Image size 1659x2212:
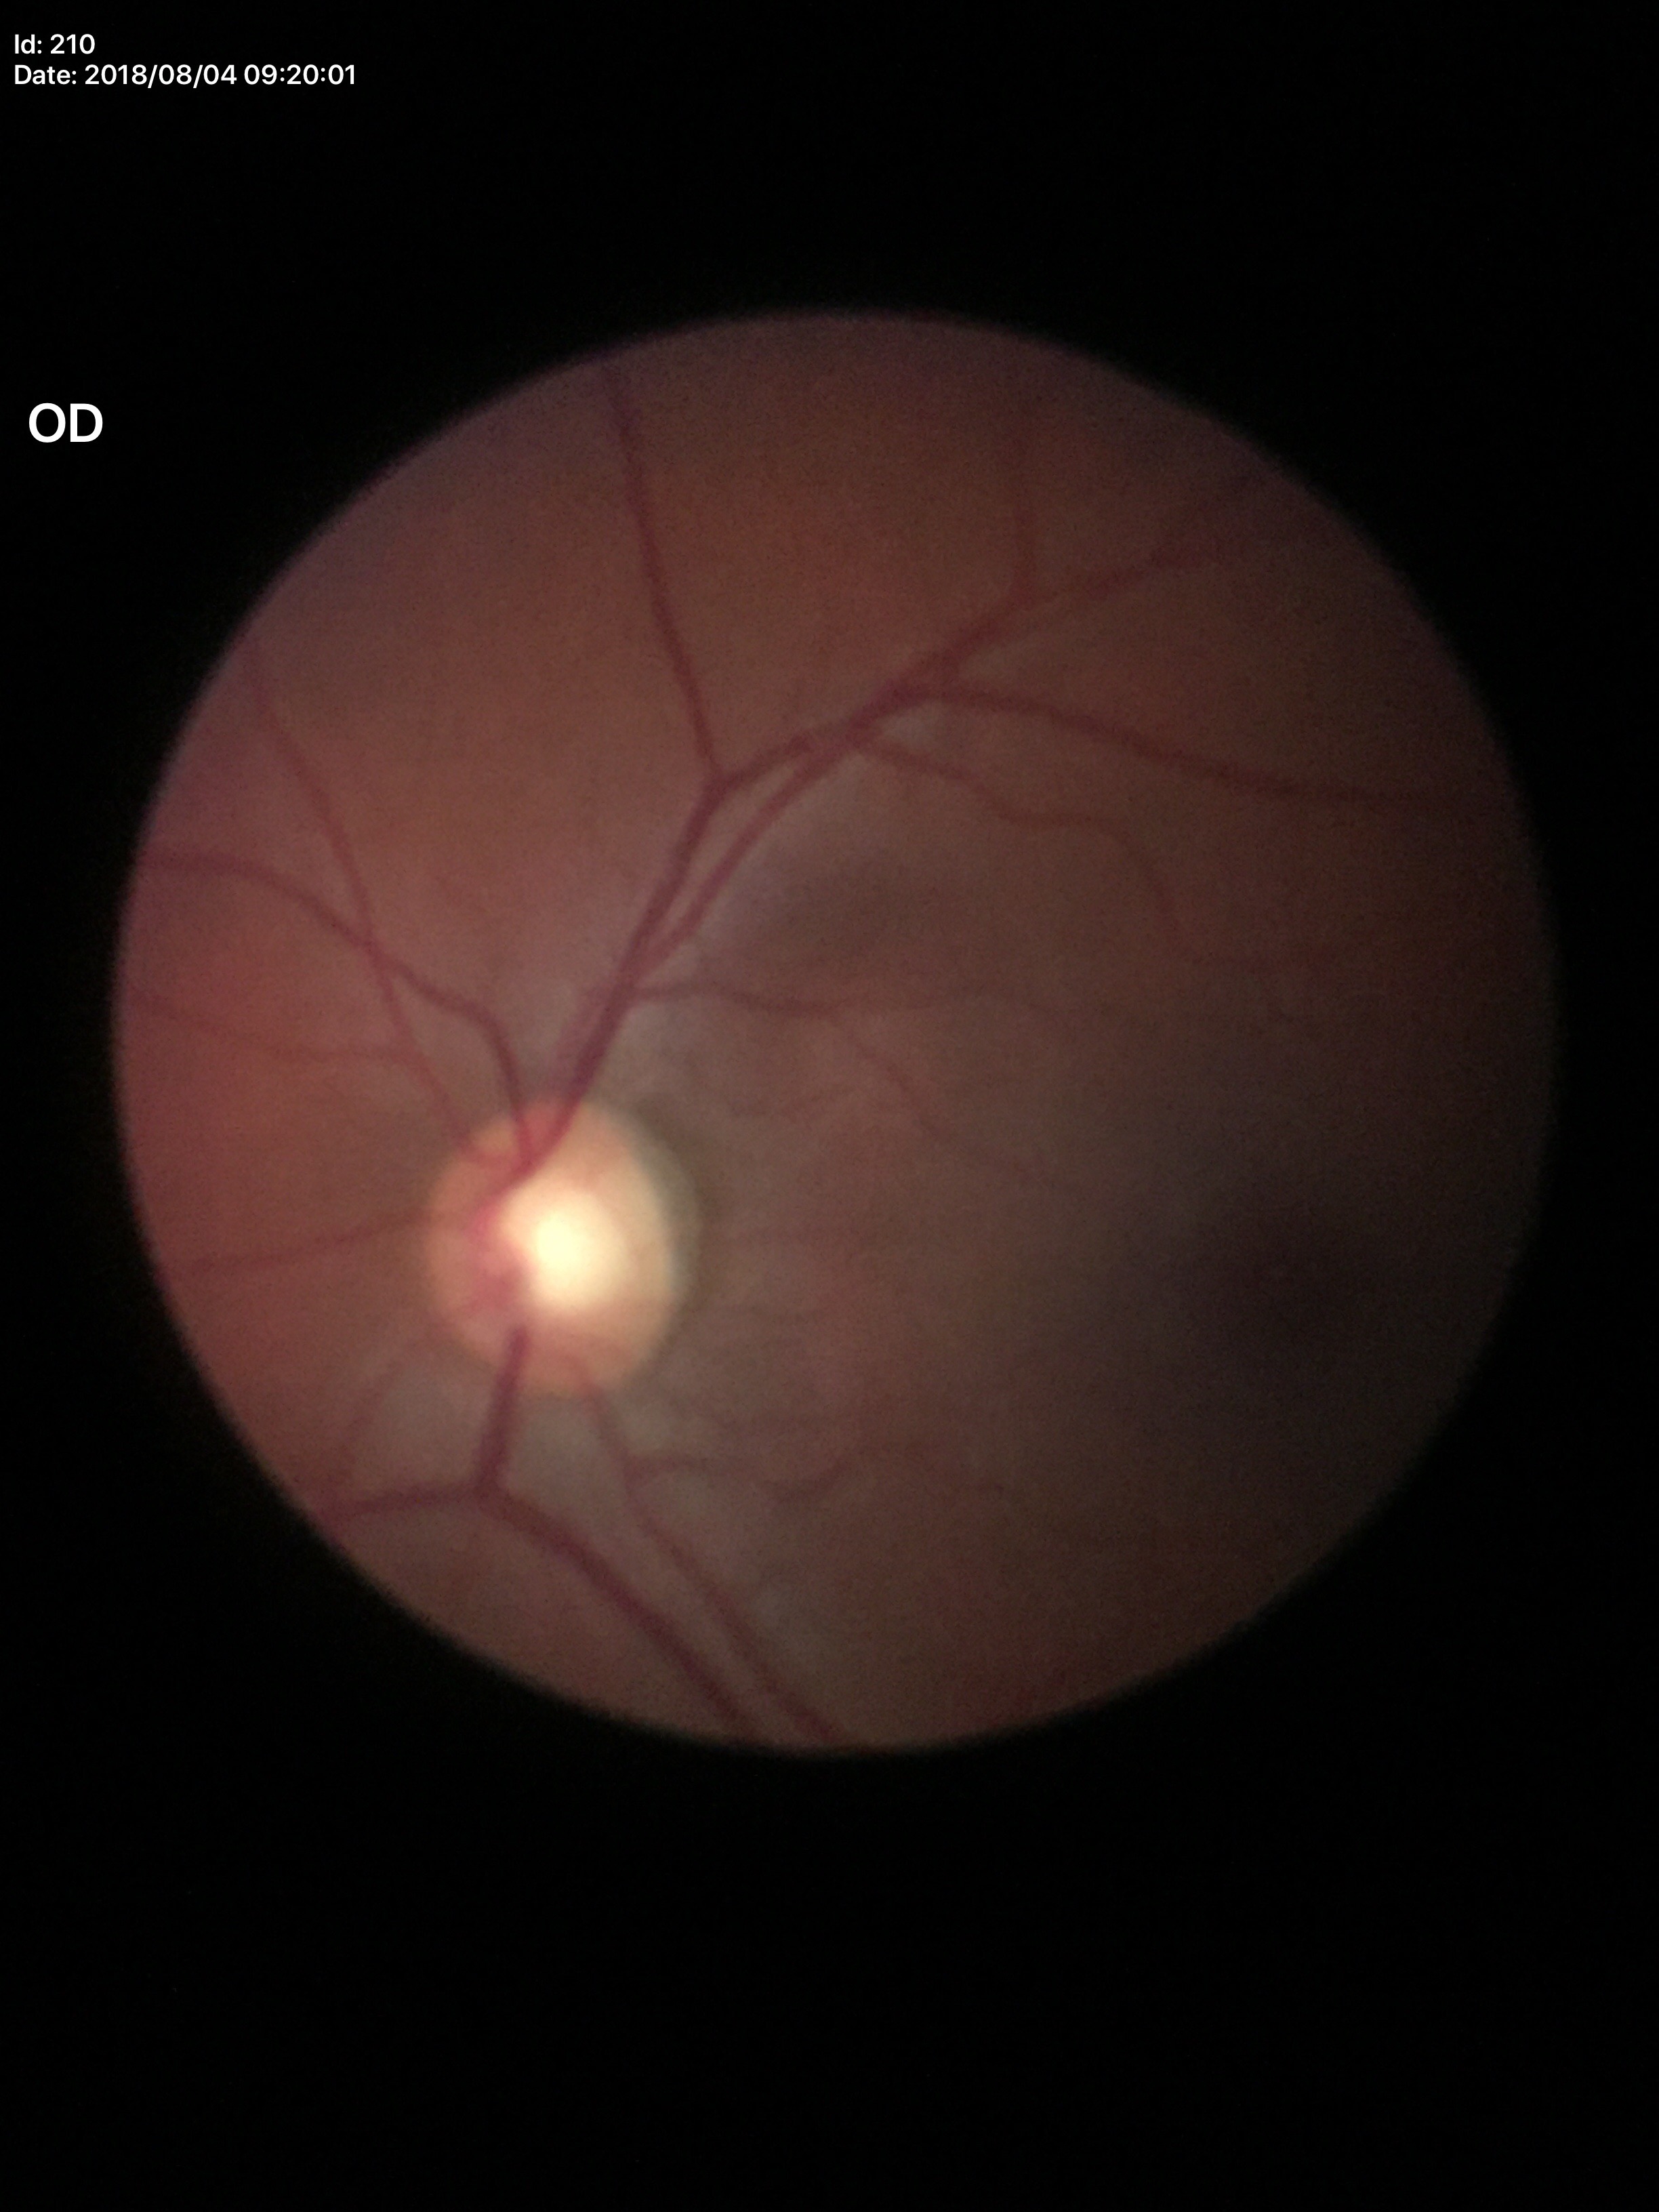

Annotations:
* Glaucoma screening — not suspect
* vertical CDR — 0.59